Topcon TRC-50DX: 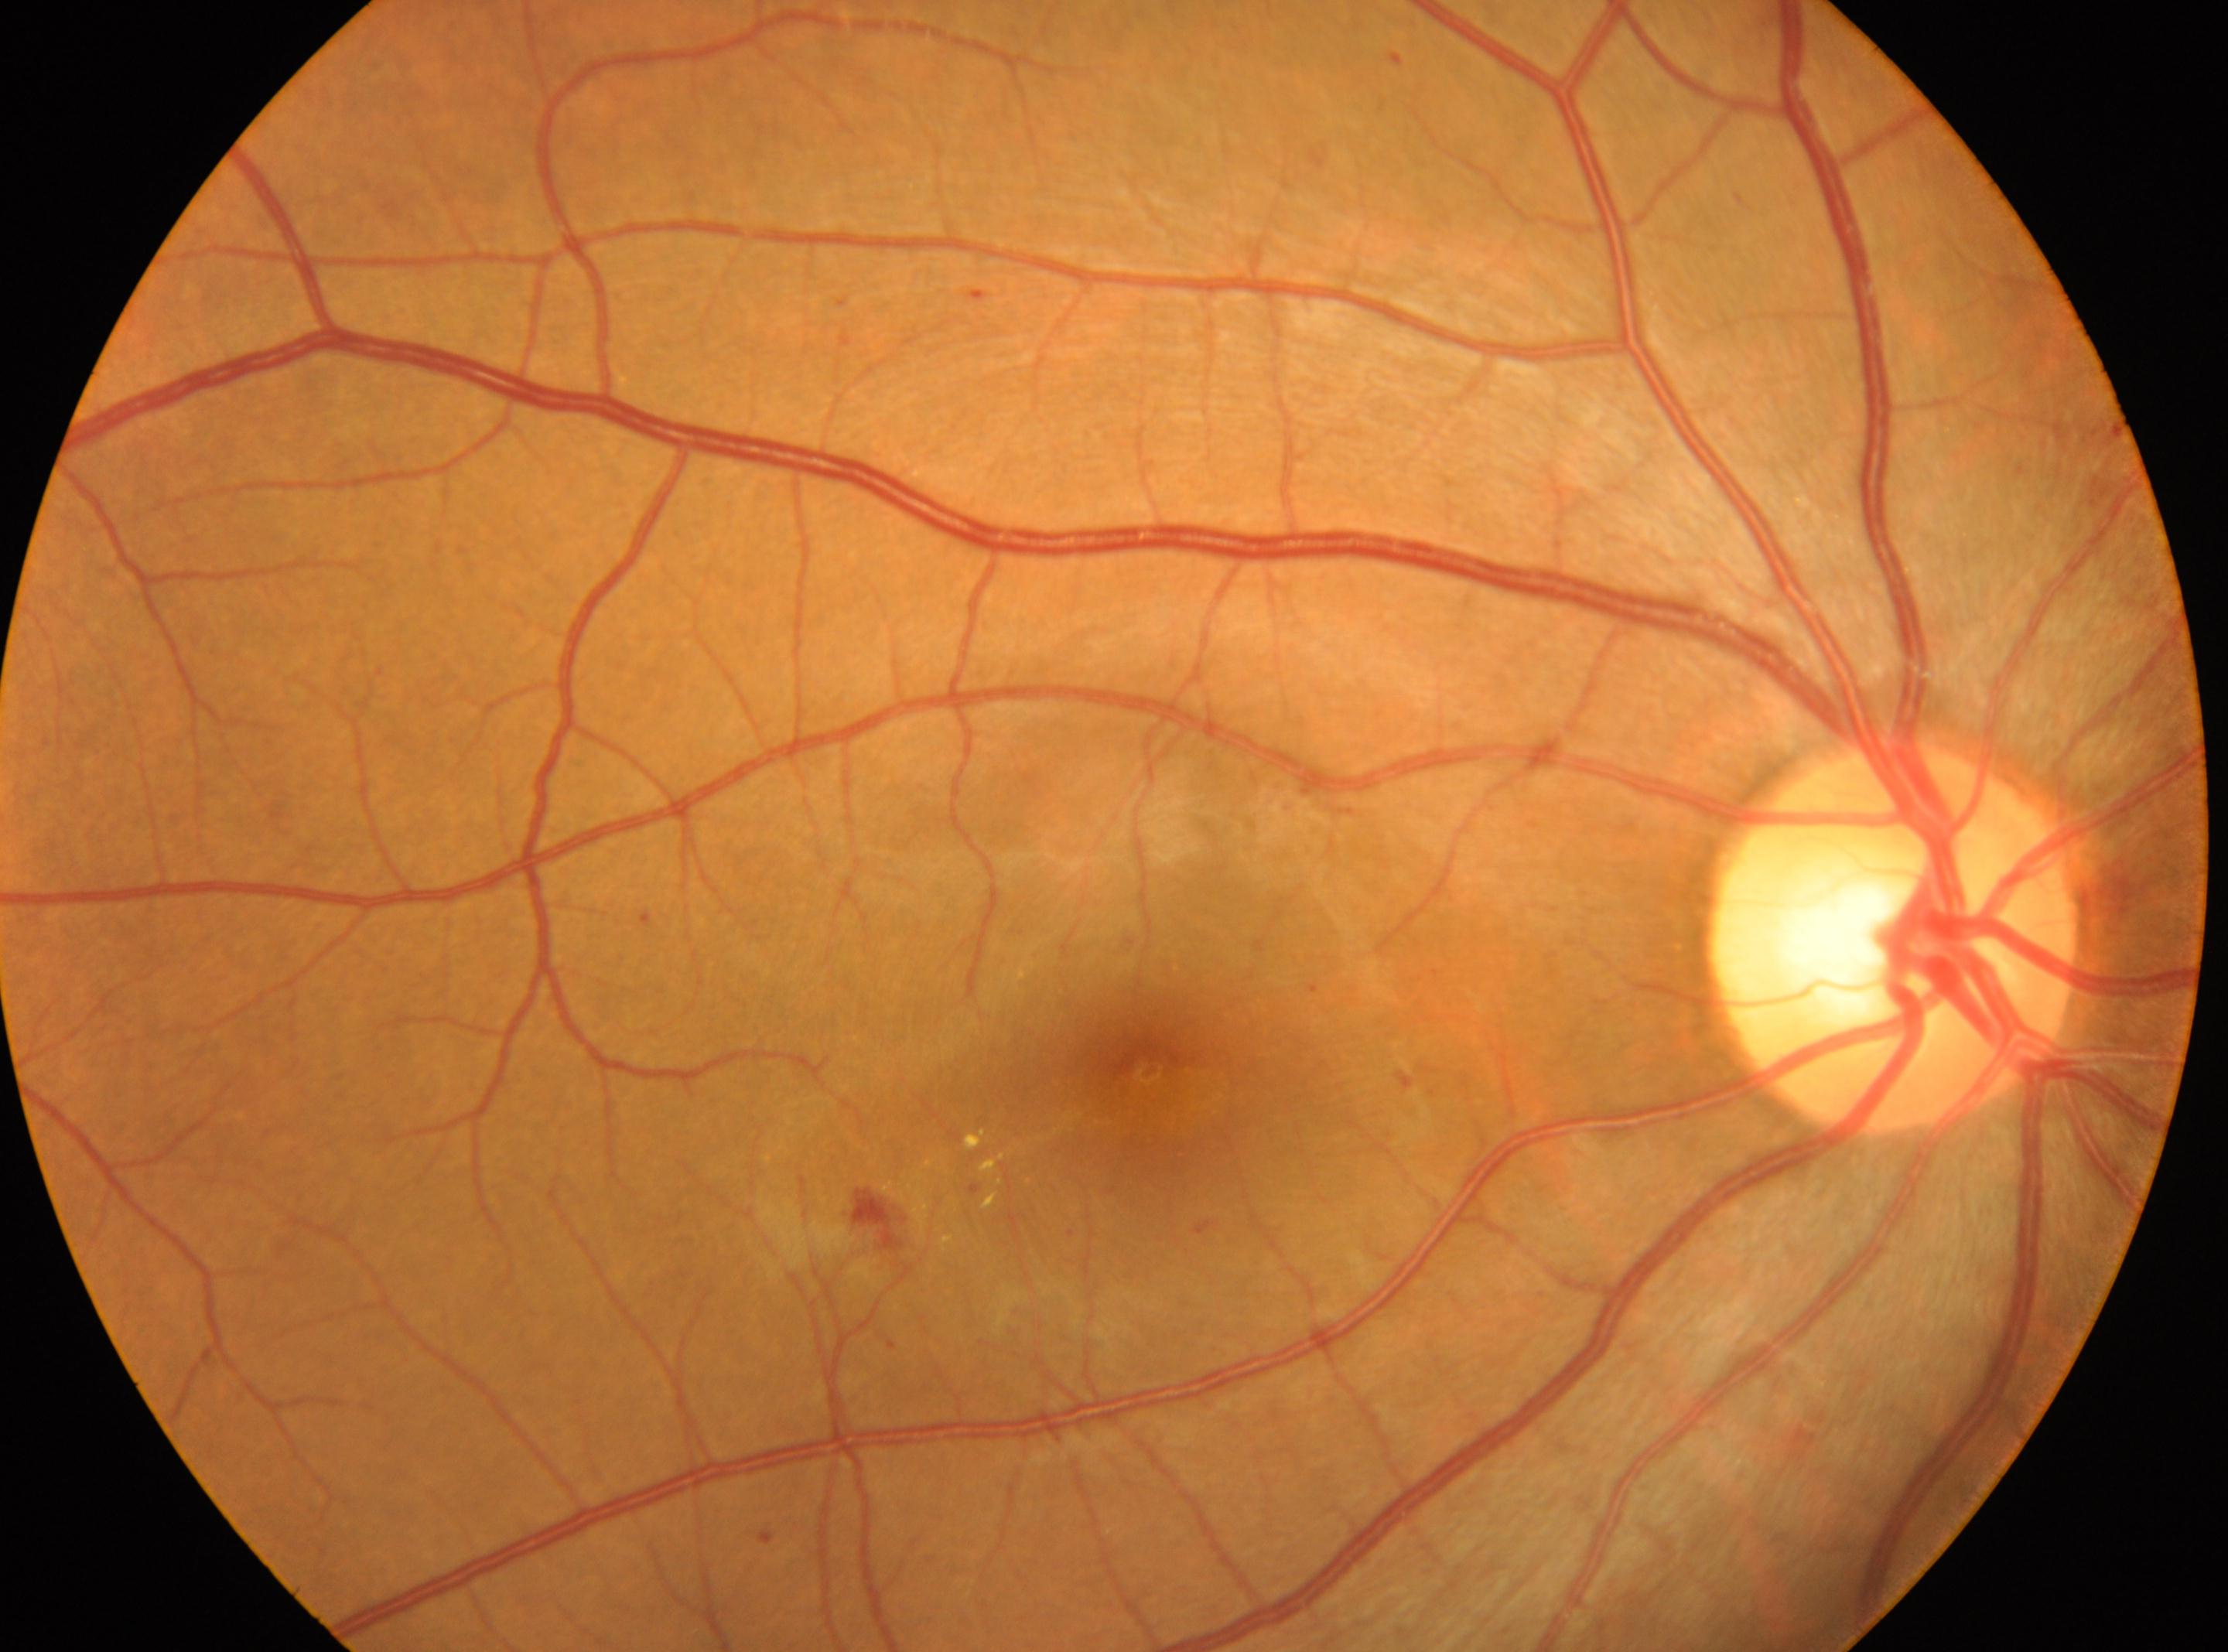 Eye: oculus dexter. Macular center located at (x: 1146, y: 1070). The optic disc center is at (x: 1893, y: 940). DR severity: grade 2 (moderate NPDR).